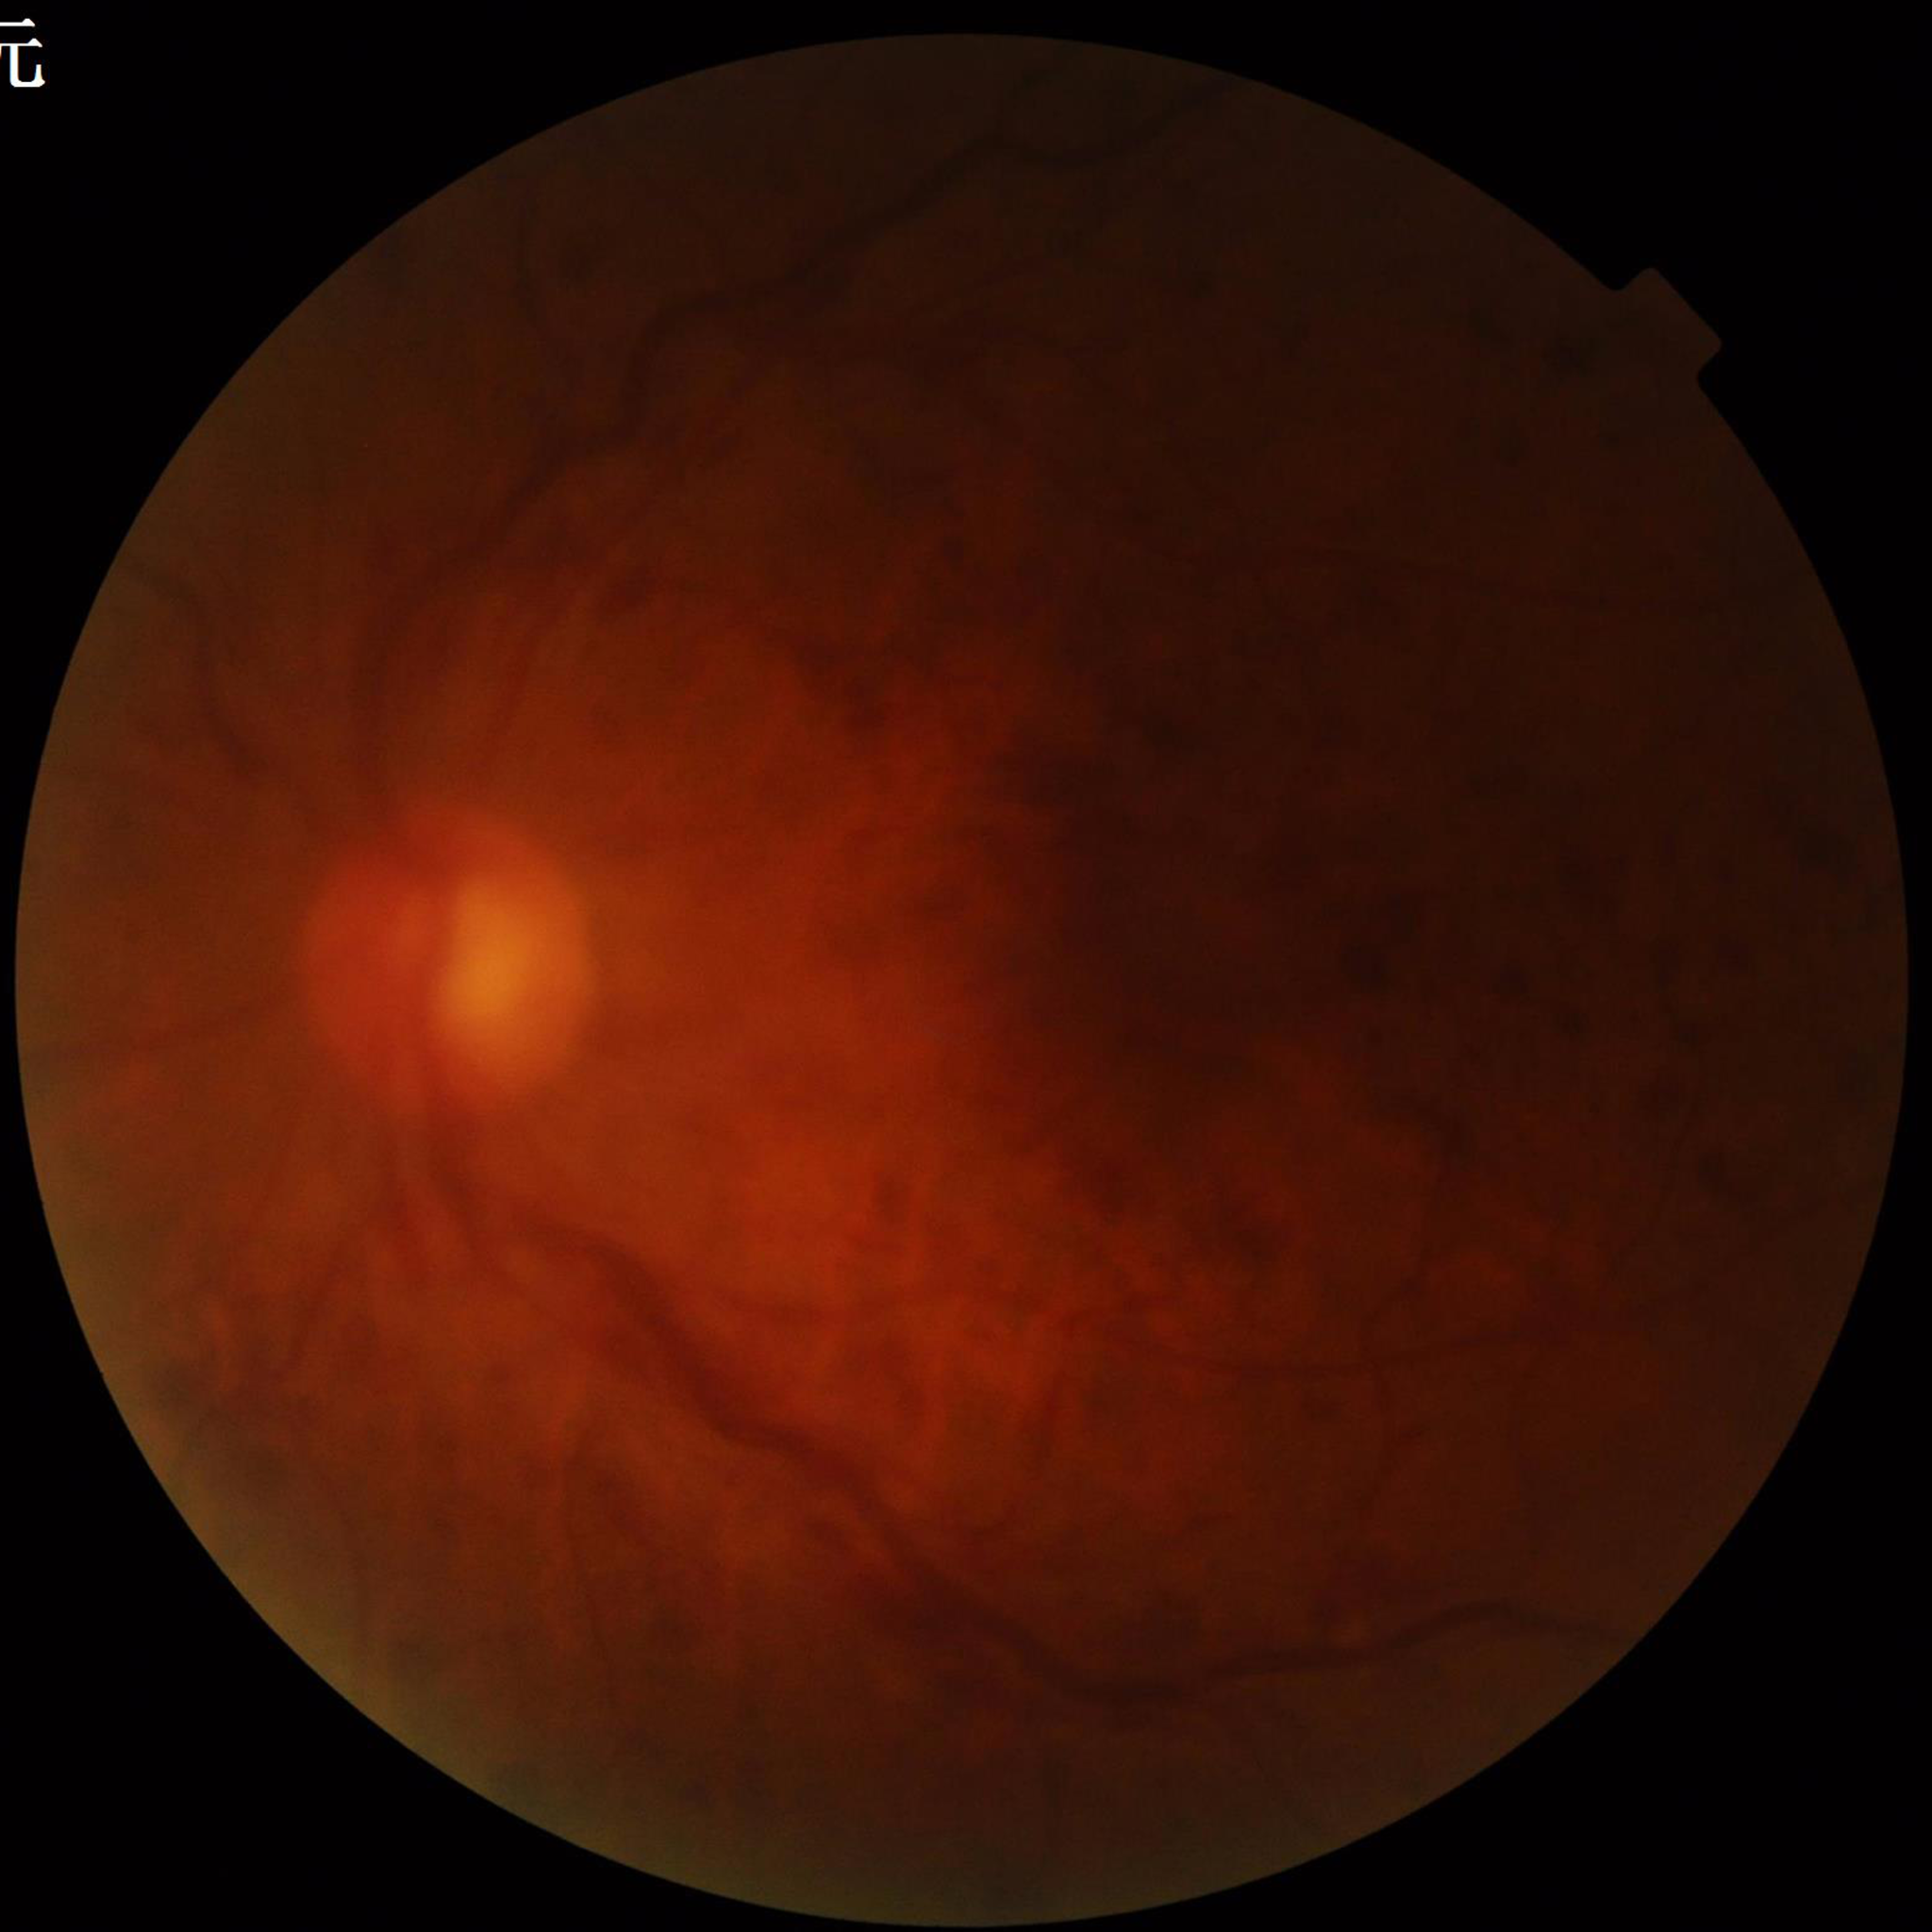 From a patient with DR.
Photo quality: illumination/color distortion present, low contrast, blur present.